848 x 848 pixels. FOV: 45 degrees — 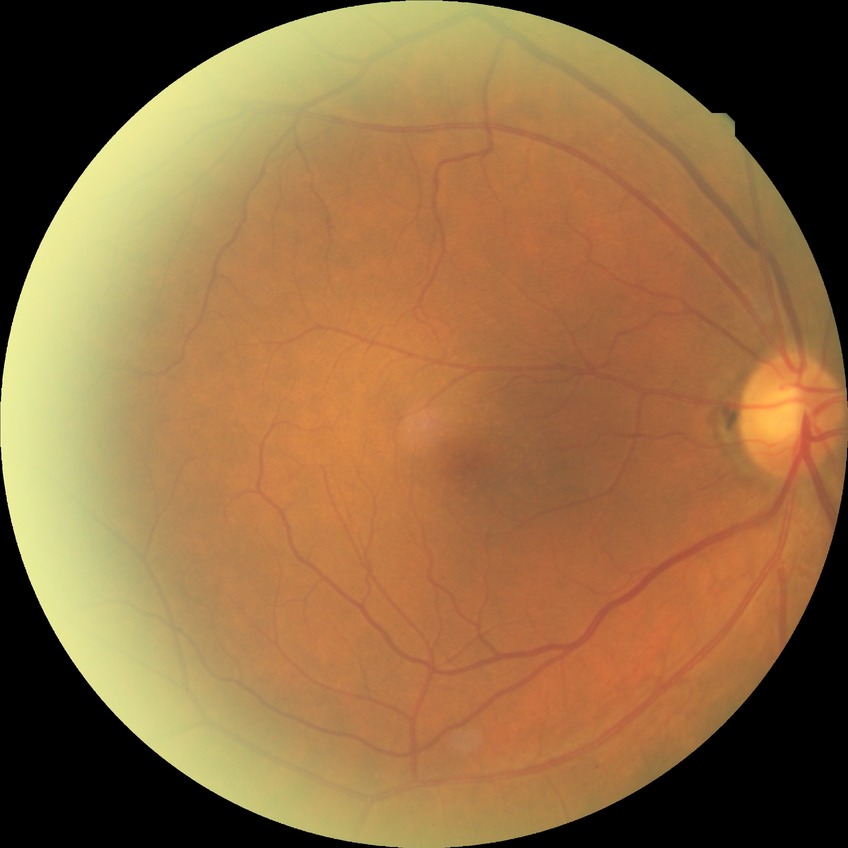

Assessment:
– DR impression — negative for DR
– DR severity — NDR